2212x1659px — 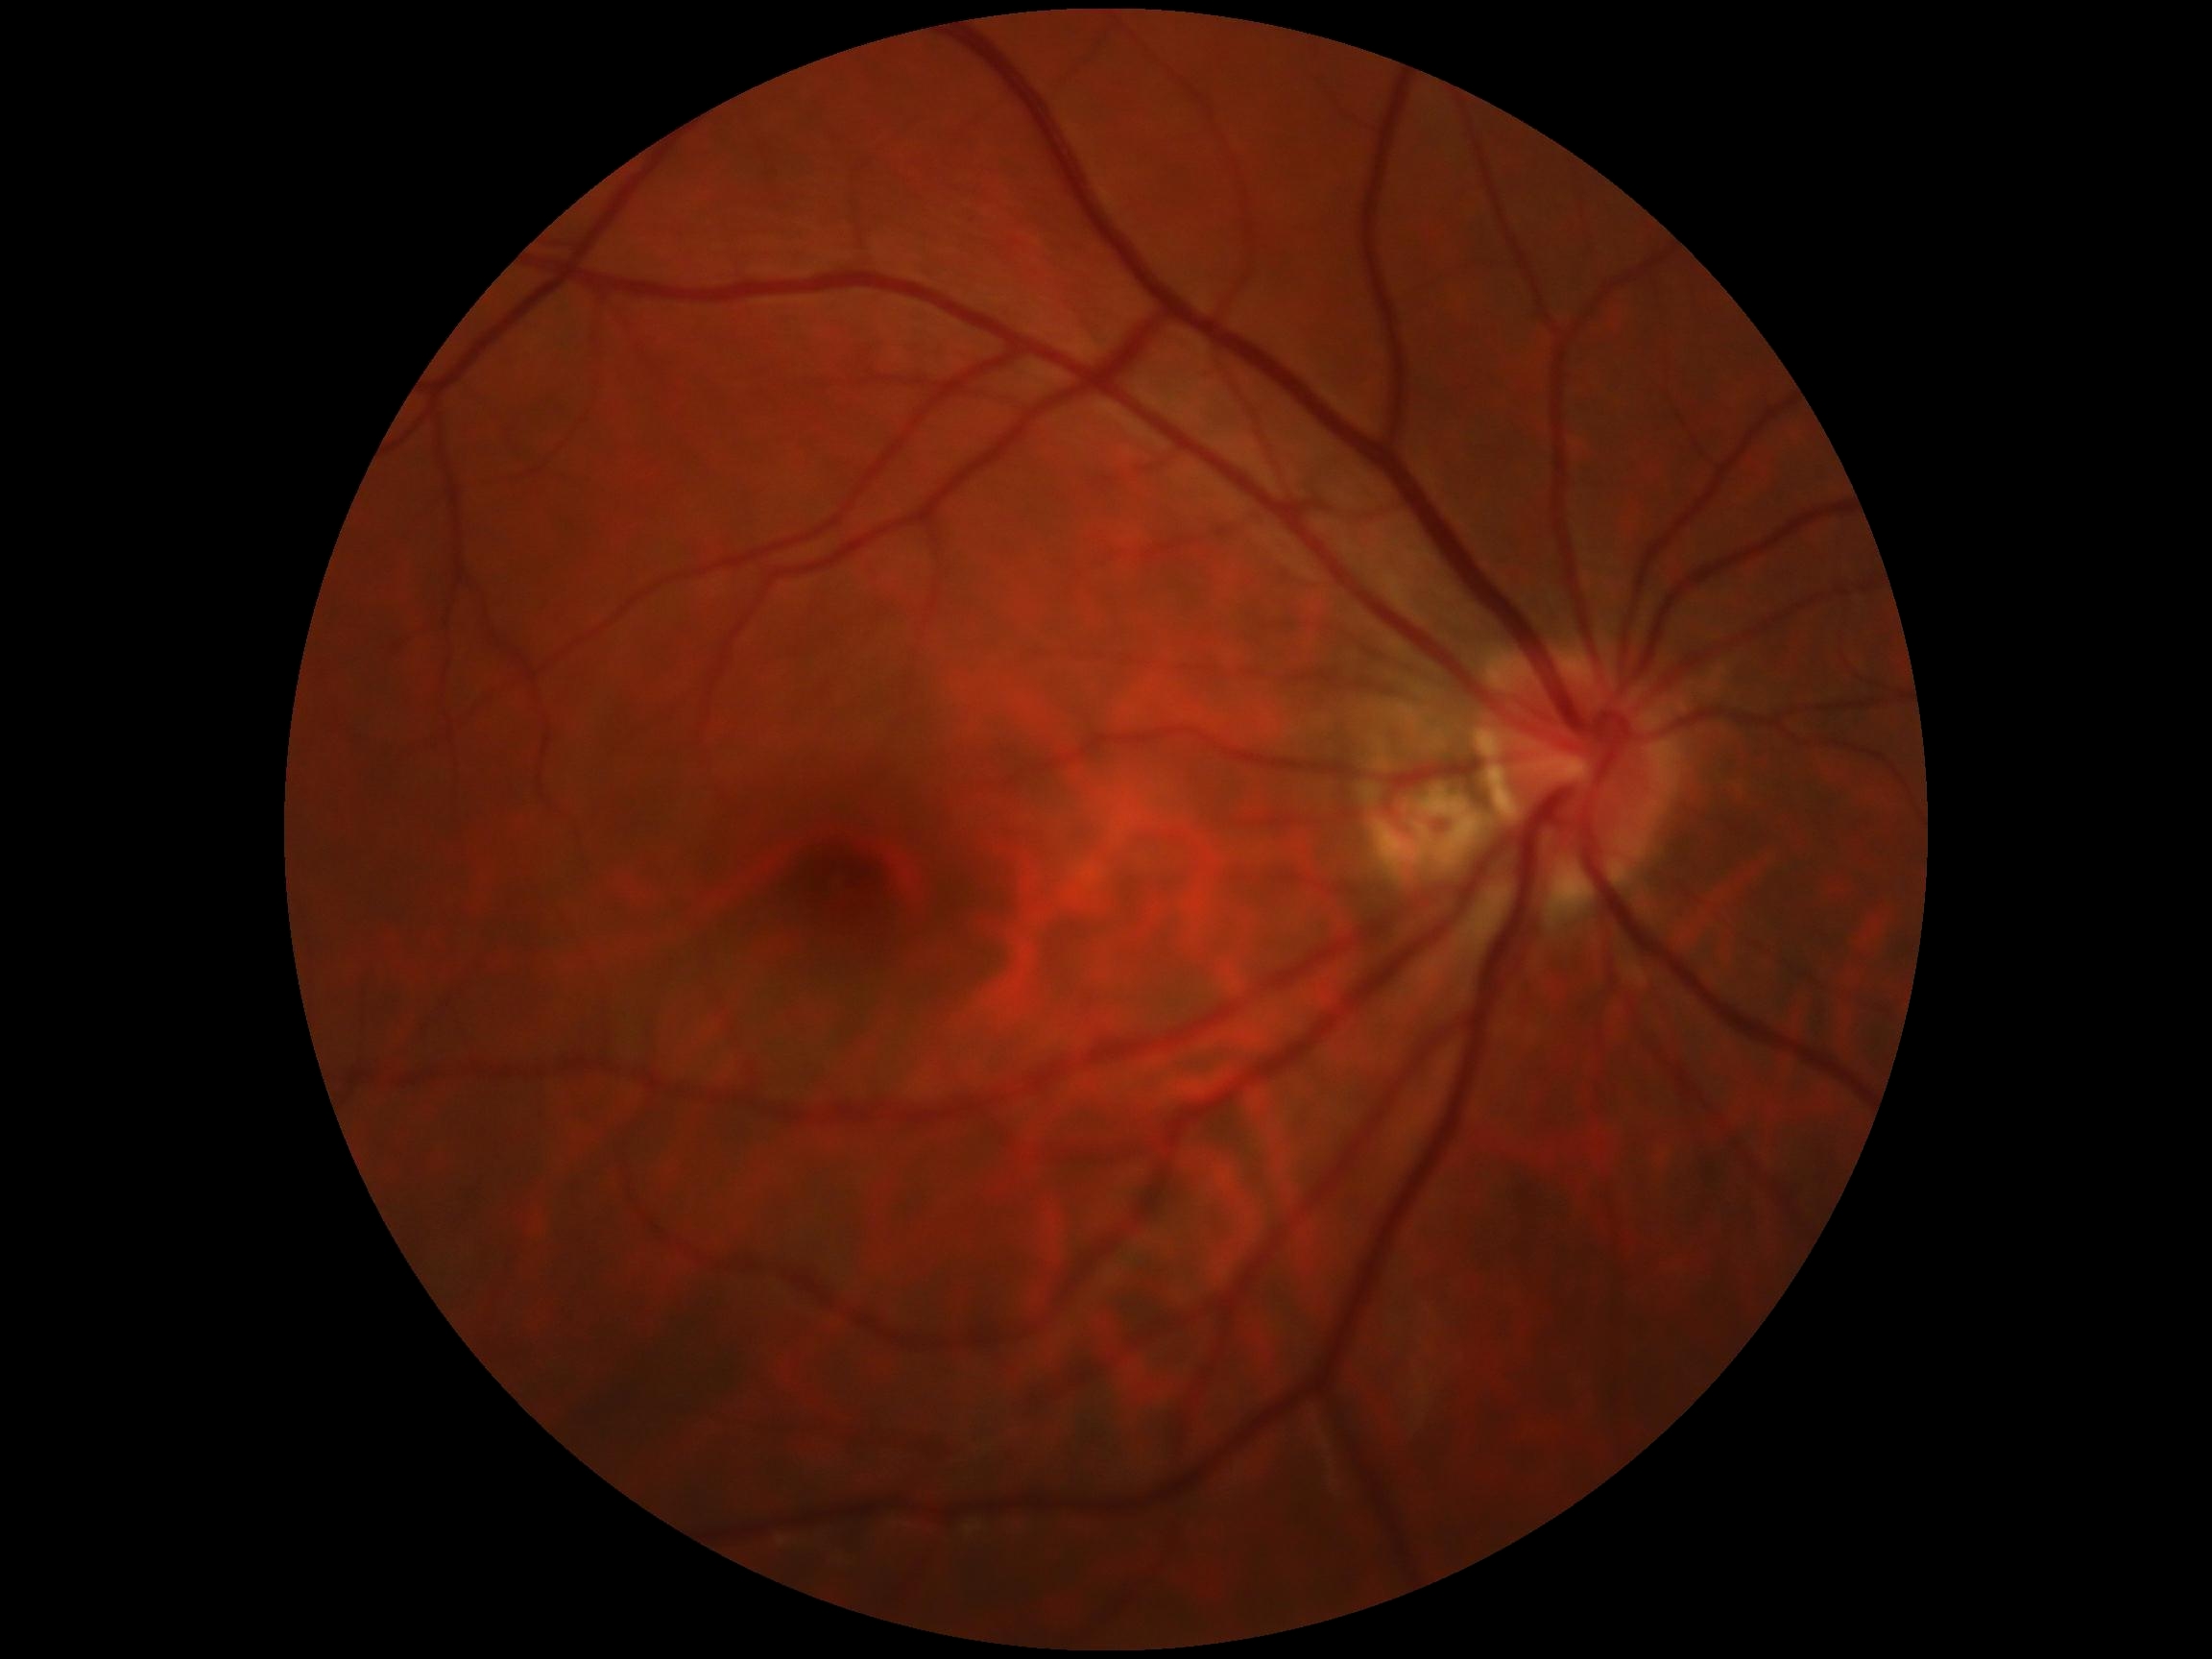 DR severity@grade 0 (no apparent retinopathy), DR impression@no signs of DR.